No pharmacologic dilation; fundus photo; FOV: 45 degrees; modified Davis grading; 848 x 848 pixels; NIDEK AFC-230 fundus camera — 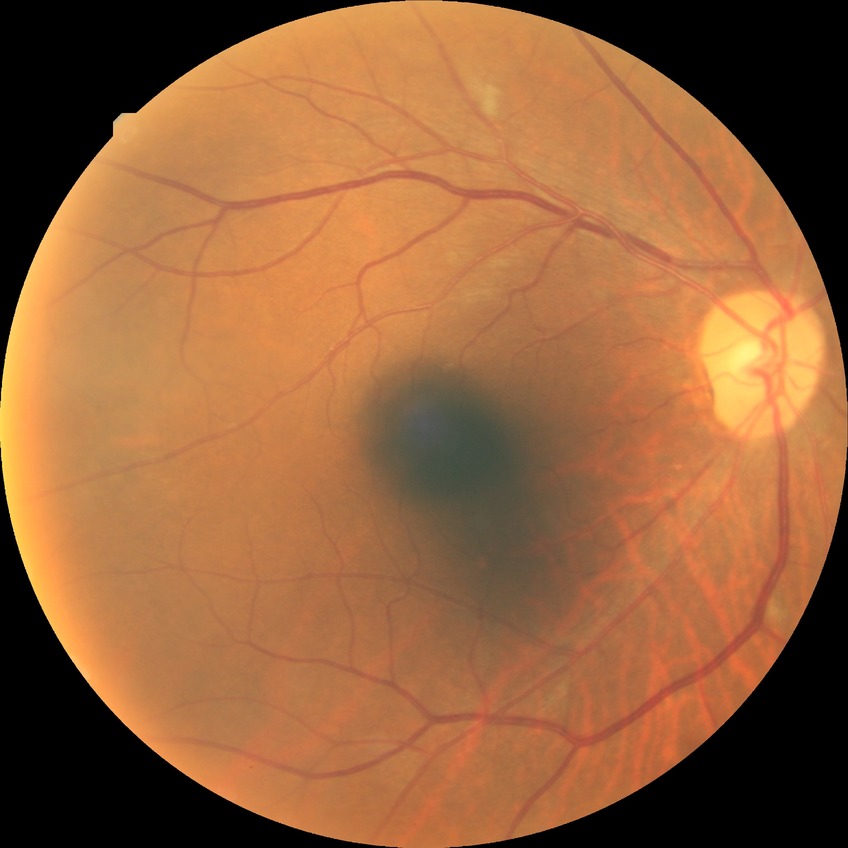
Findings:
• Davis grading: pre-proliferative diabetic retinopathy